Wide-field fundus photograph of an infant: 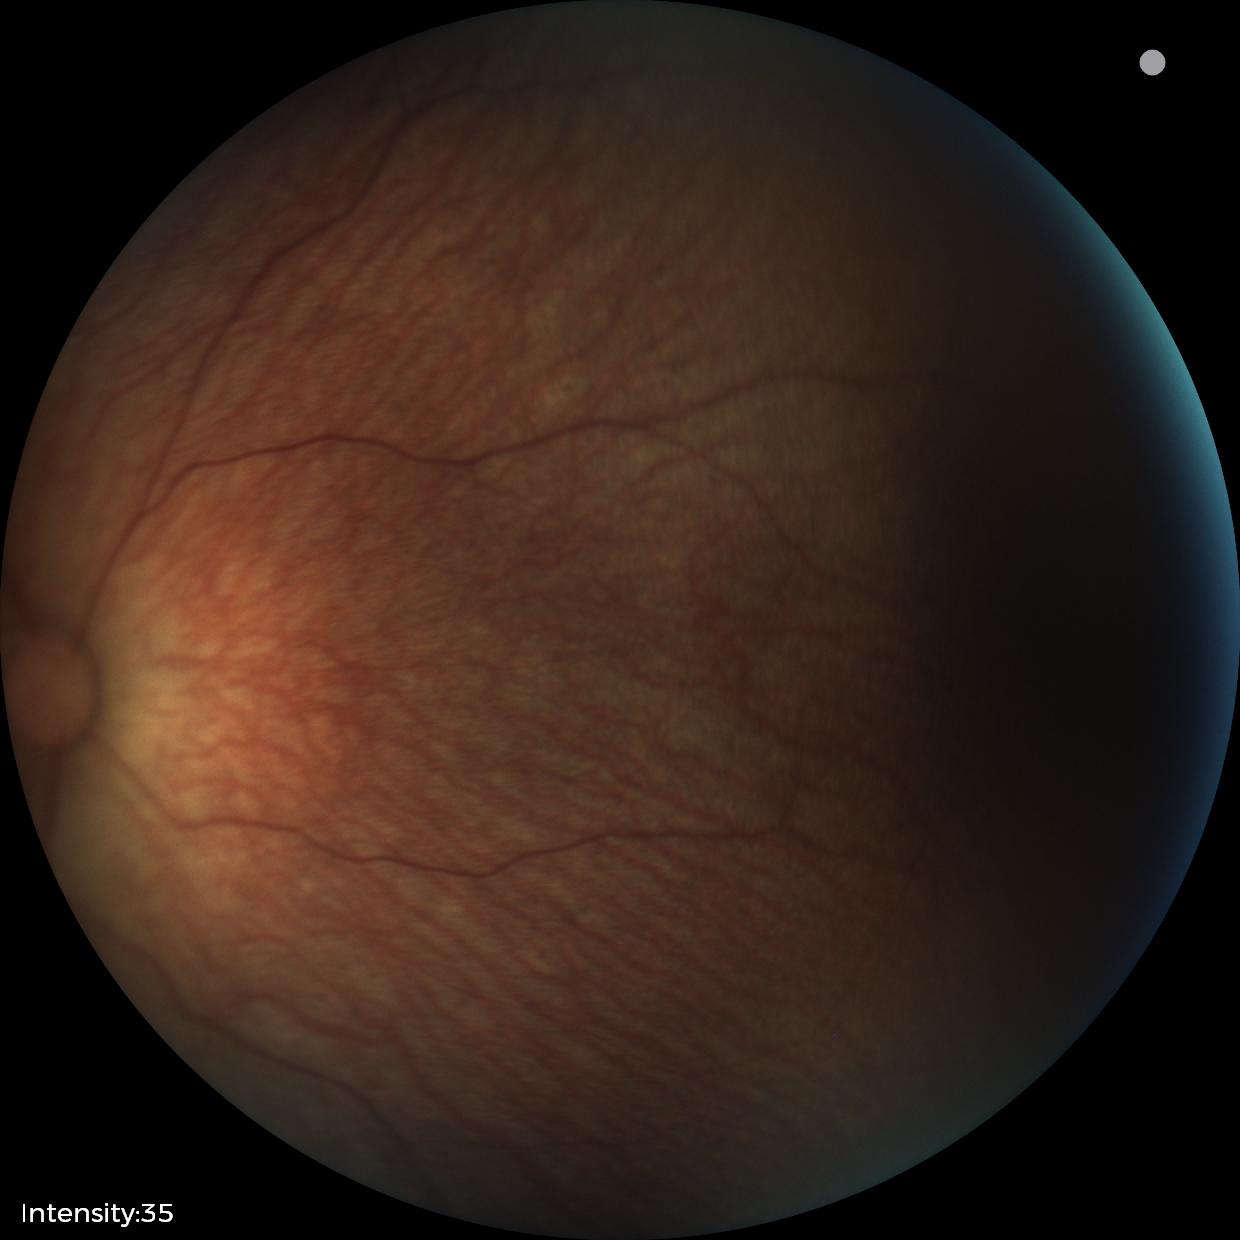
Screening: physiological appearance with no retinal pathology.